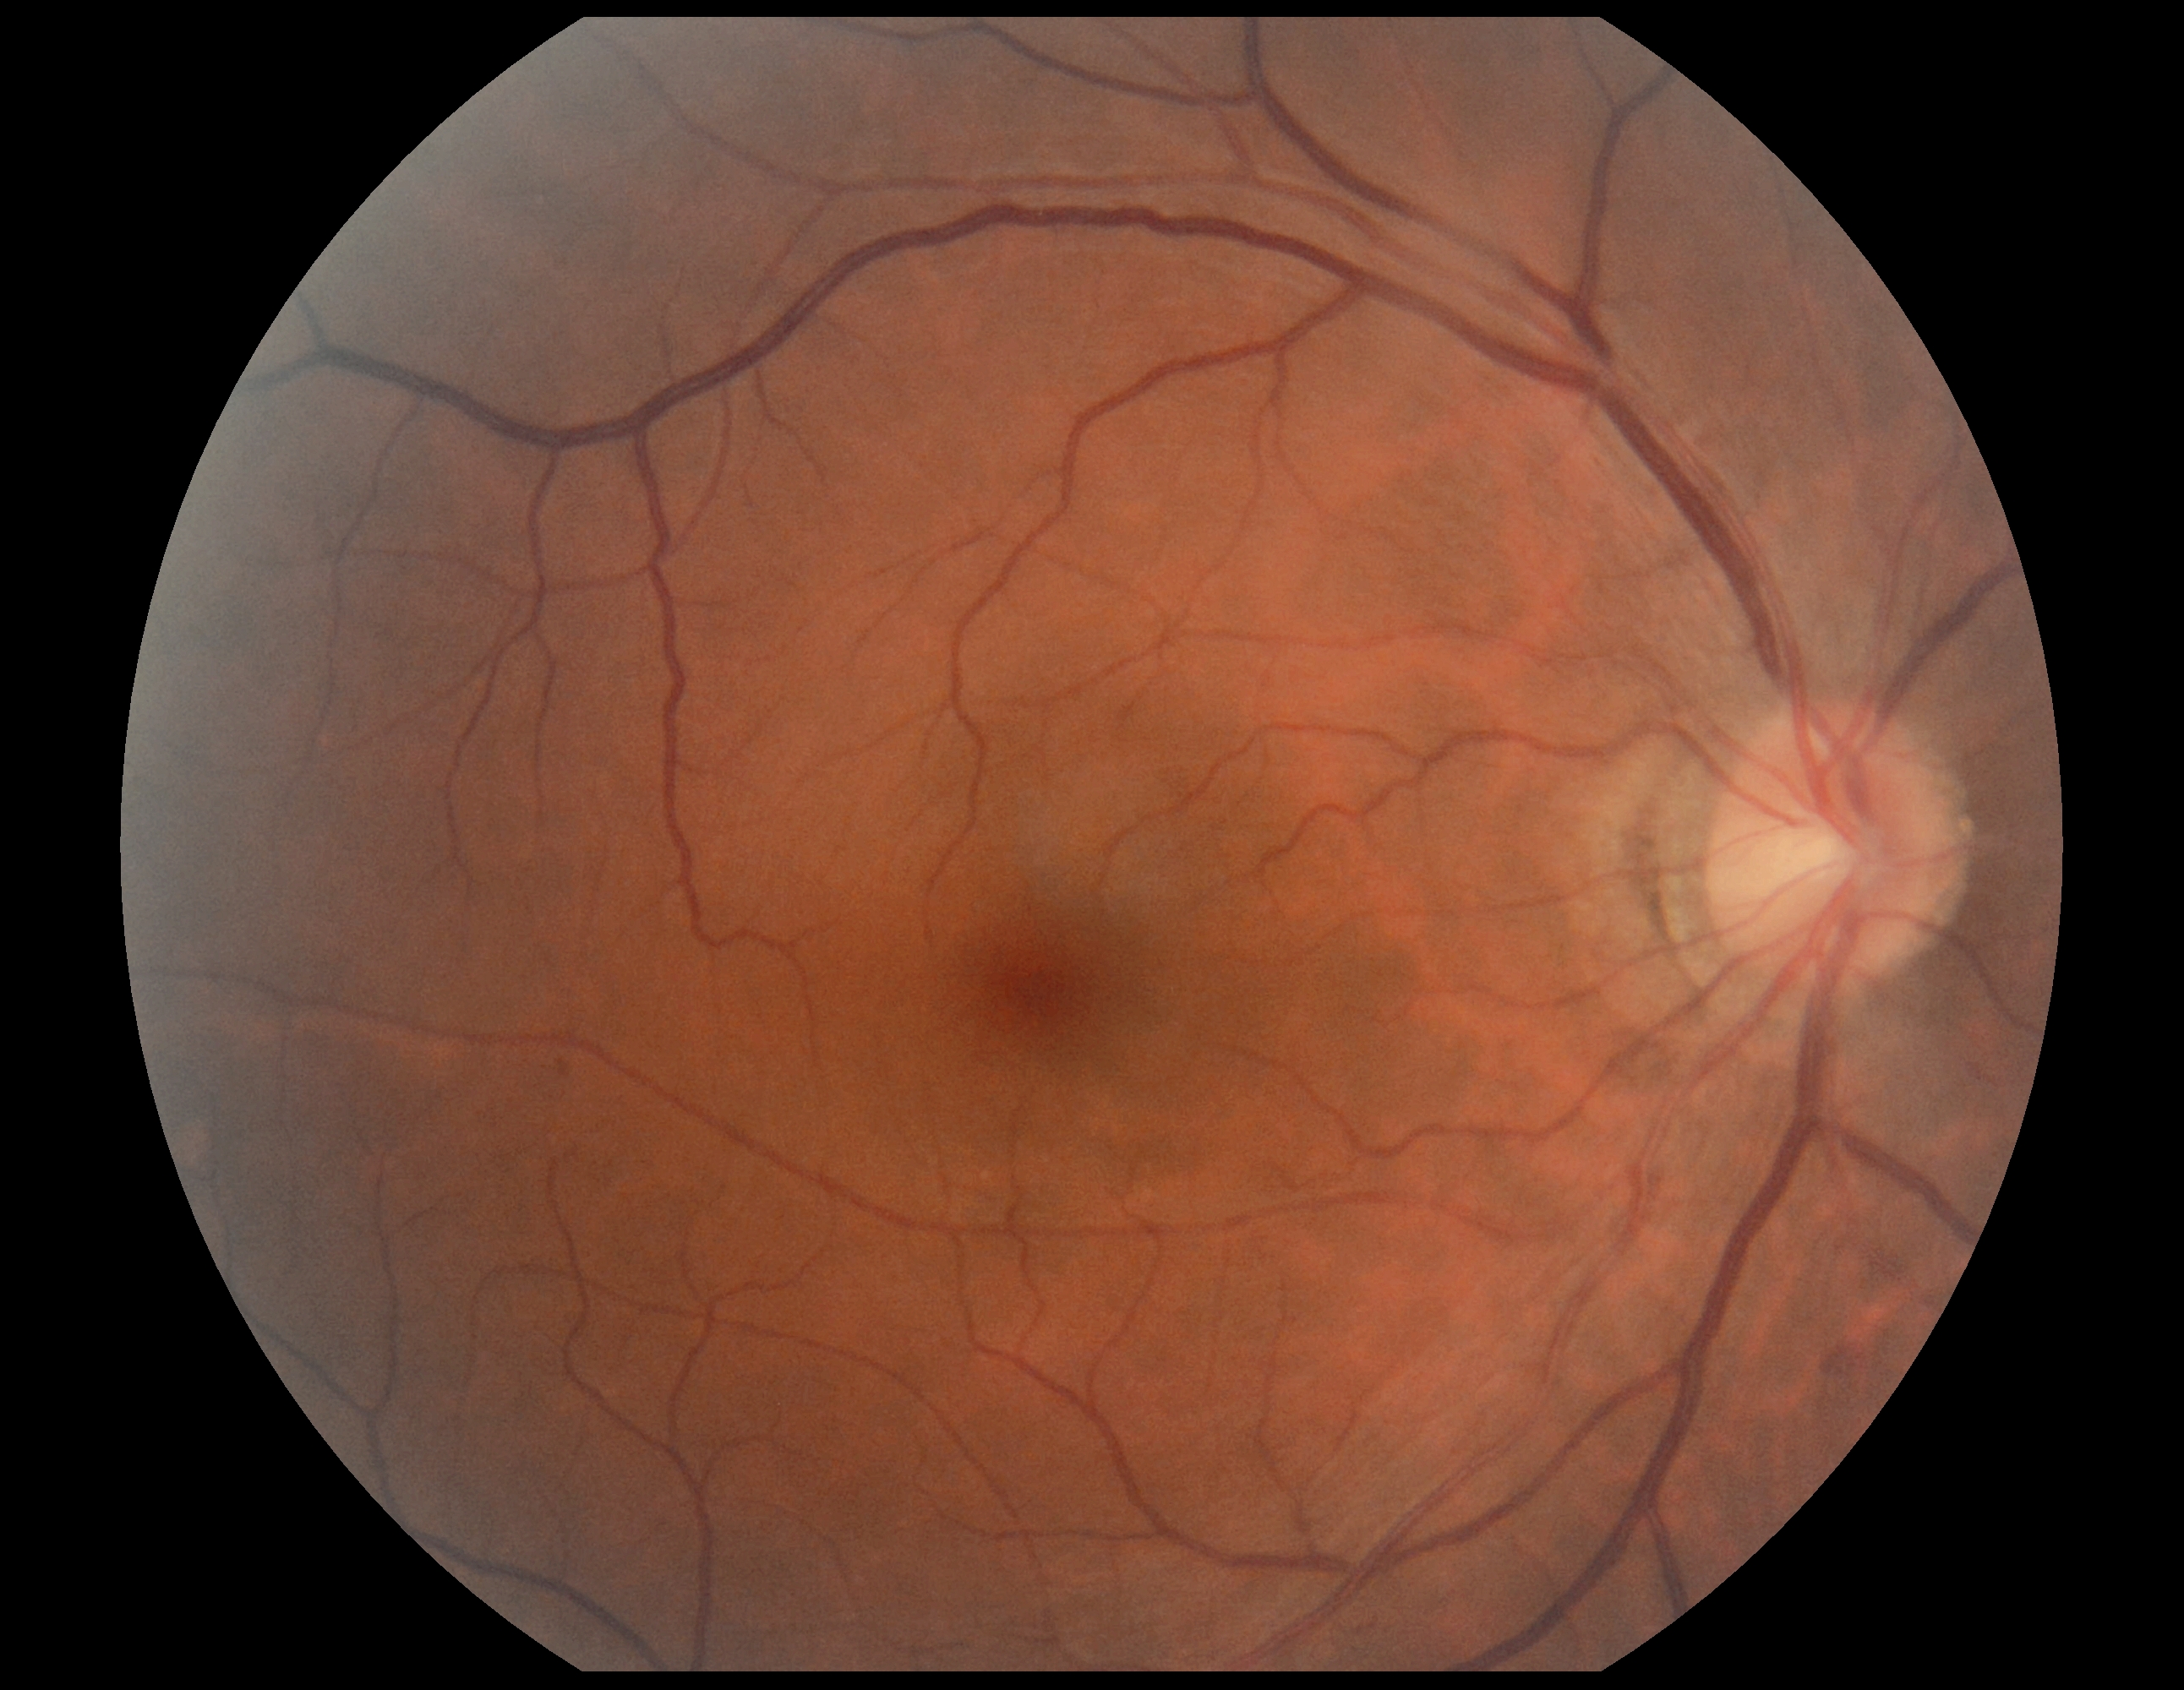 DR: 2.